Wide-field fundus photograph of an infant. Captured with the Phoenix ICON (100° field of view) — 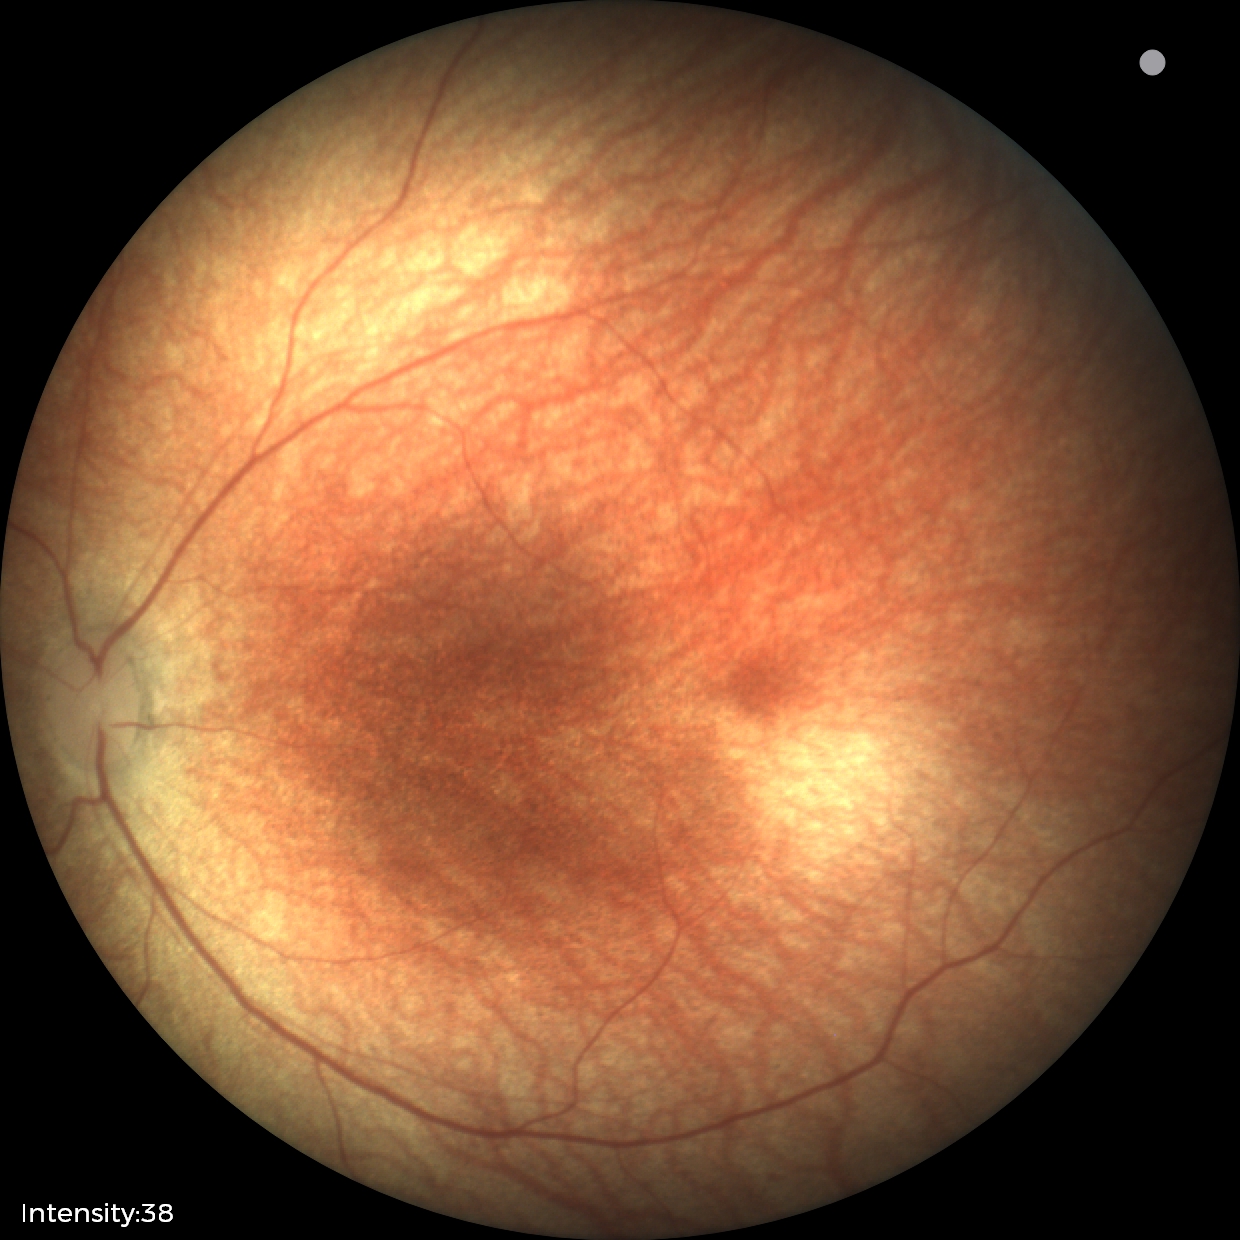

Normal screening examination.